Optic nerve head crop; CFP:
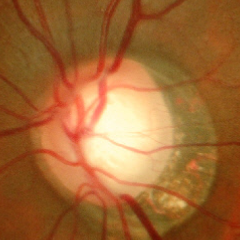
Diagnosis = early glaucomatous optic neuropathy.